Phoenix ICON wide-field infant fundus image — 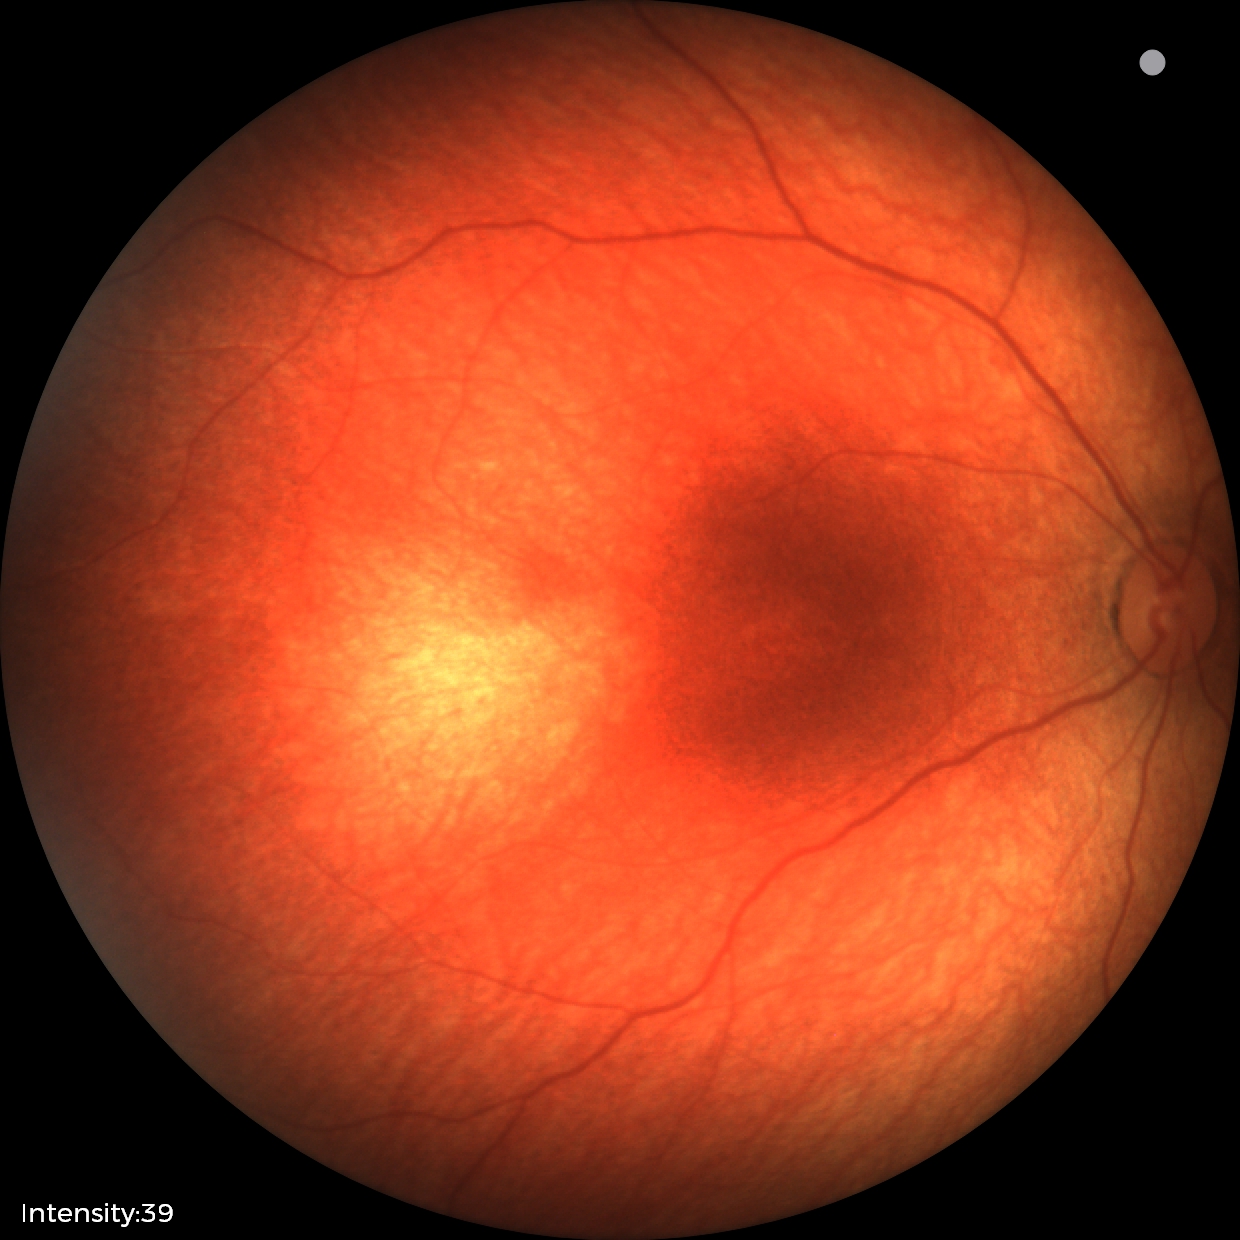

Diagnosis = normal.